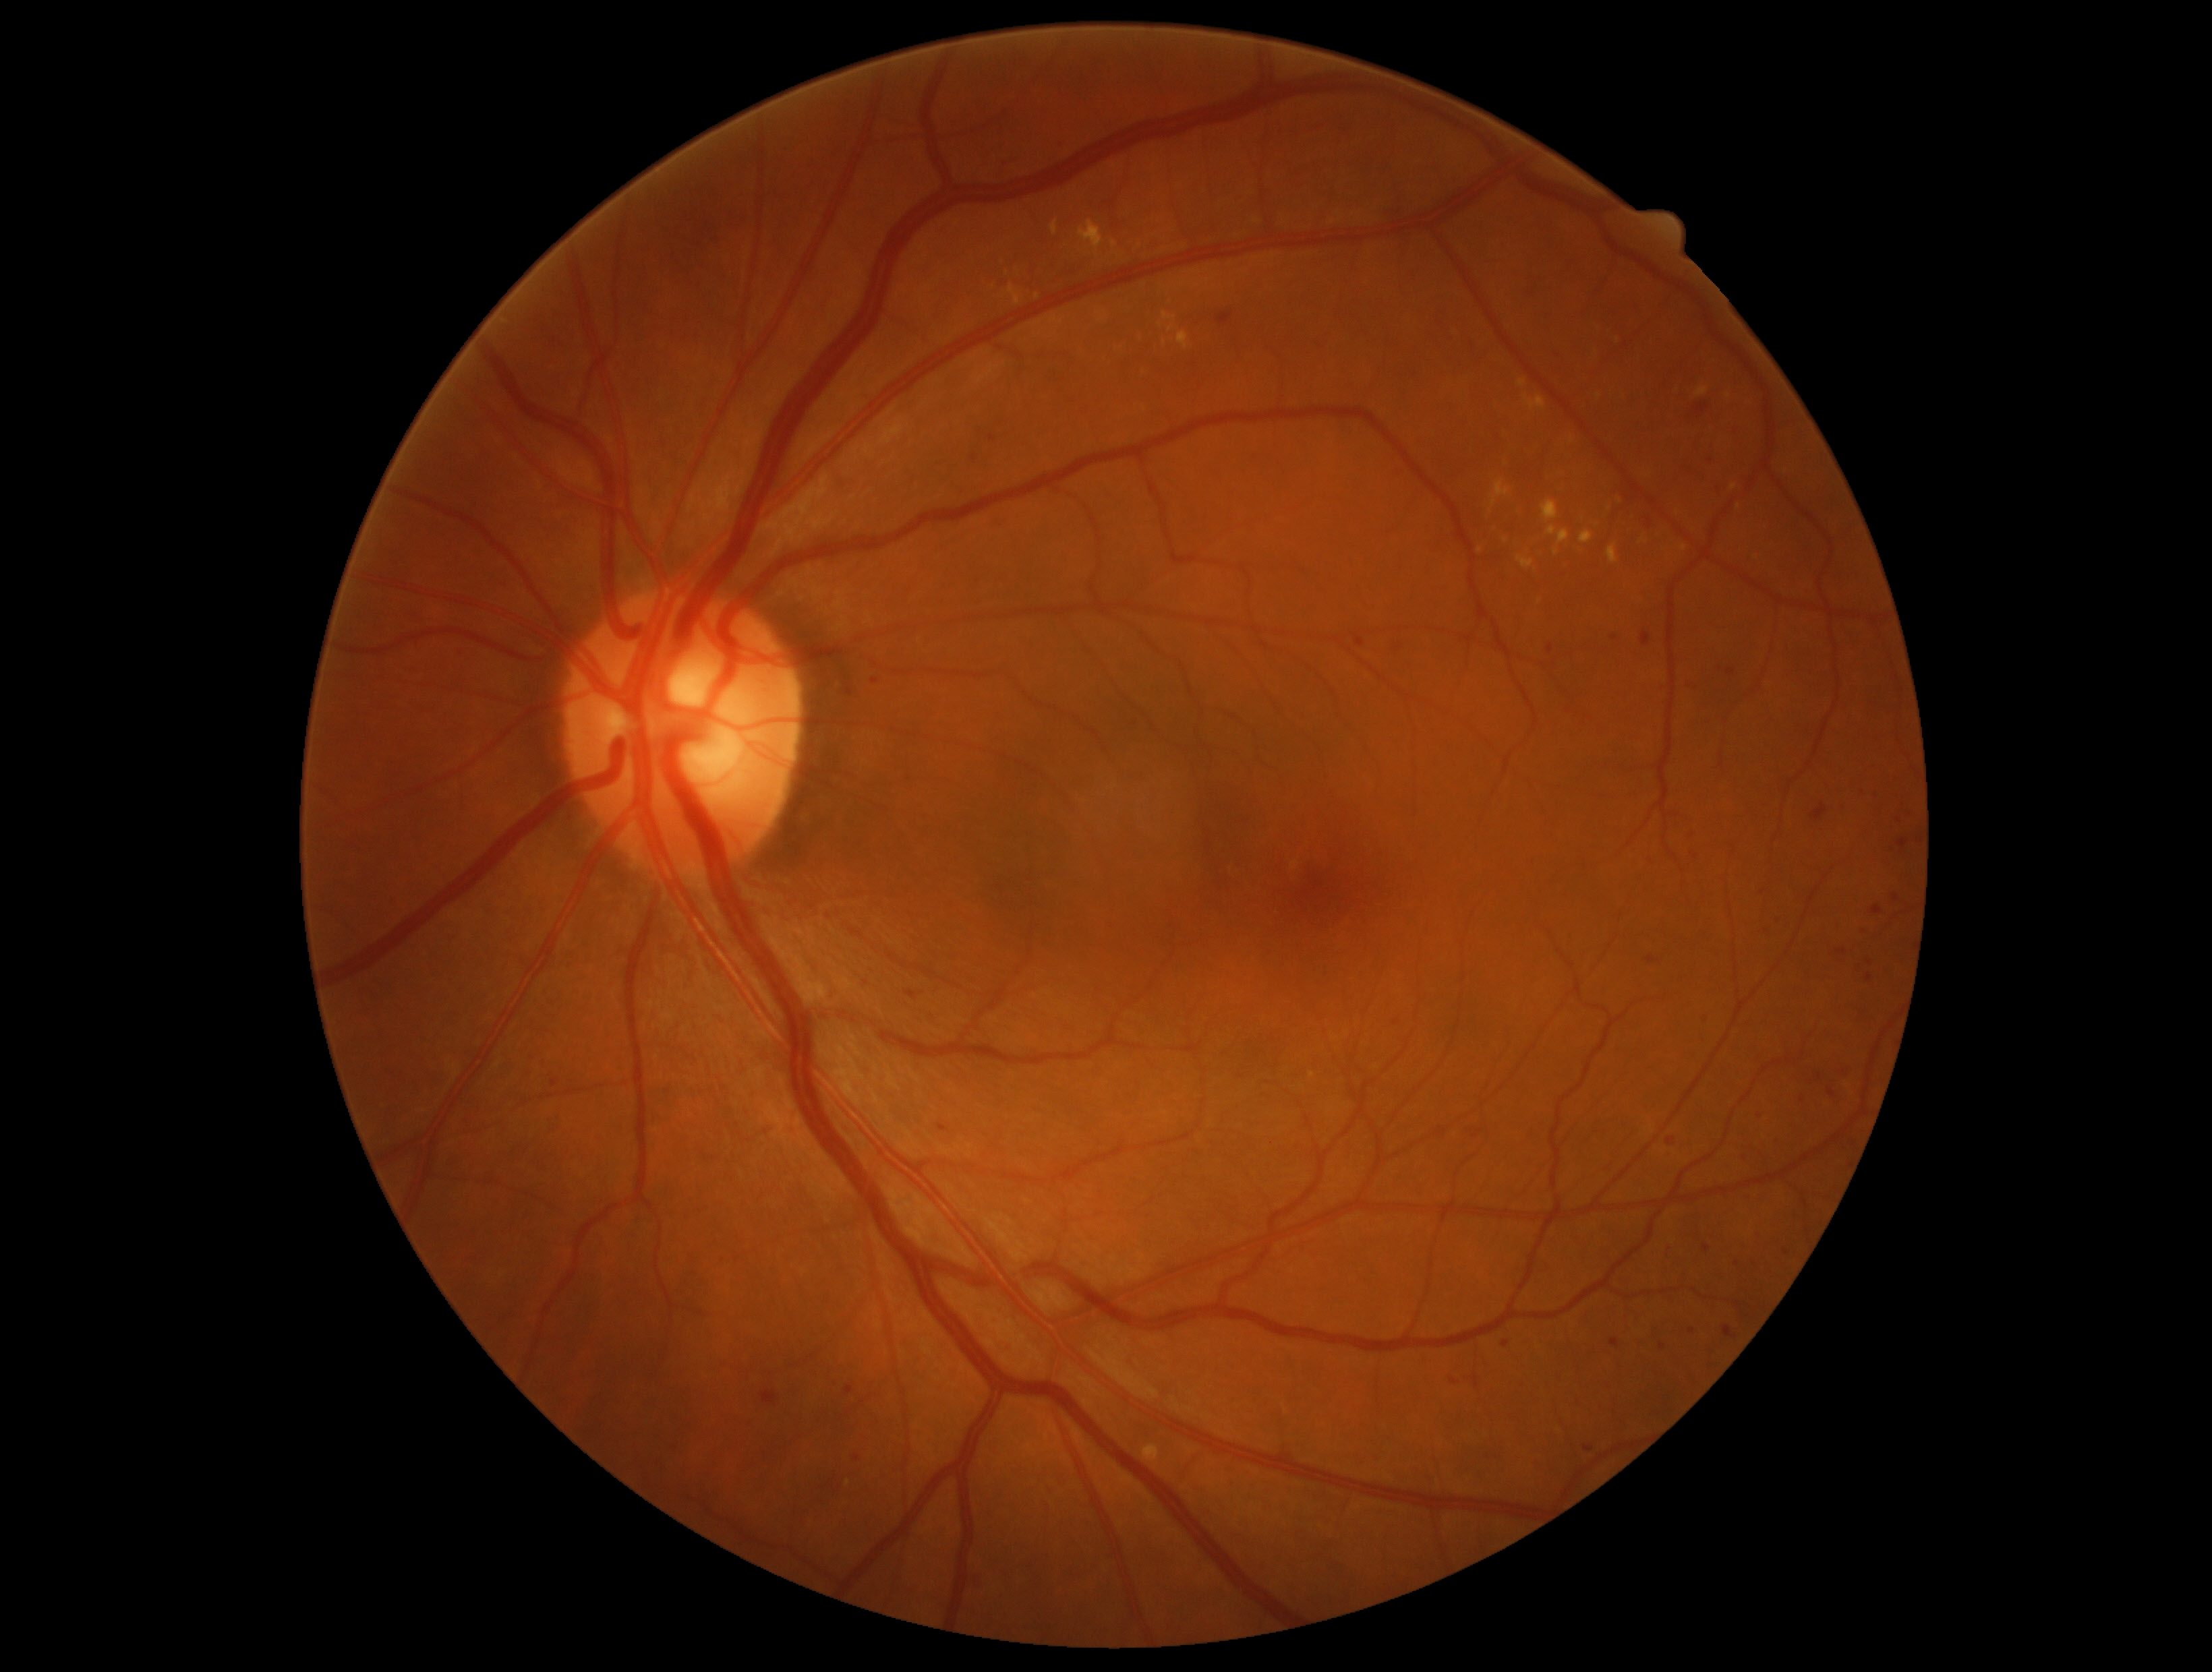

Findings:
- DR class — non-proliferative diabetic retinopathy
- retinopathy grade — 2 (moderate NPDR) — more than just microaneurysms but less than severe NPDR